Captured with the Clarity RetCam 3 (130° field of view). 640 by 480 pixels. Pediatric retinal photograph (wide-field)
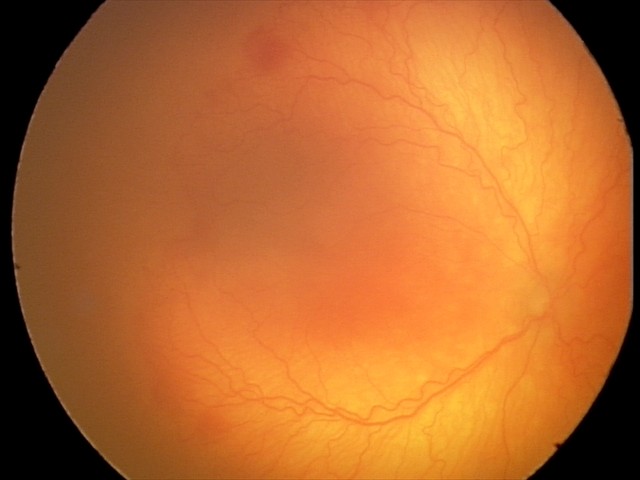

Plus disease was diagnosed. Diagnosis from this screening exam: aggressive retinopathy of prematurity — rapidly progressive severe ROP with prominent plus disease, often without classic stage progression.